Fundus photo. Axial length 23.51 mm. Captured on a Topcon TRC-NW400 fundus camera. 30° FOV. Corneal thickness: 479 µm. Non-mydriatic acquisition. 2212 x 1661 pixels.
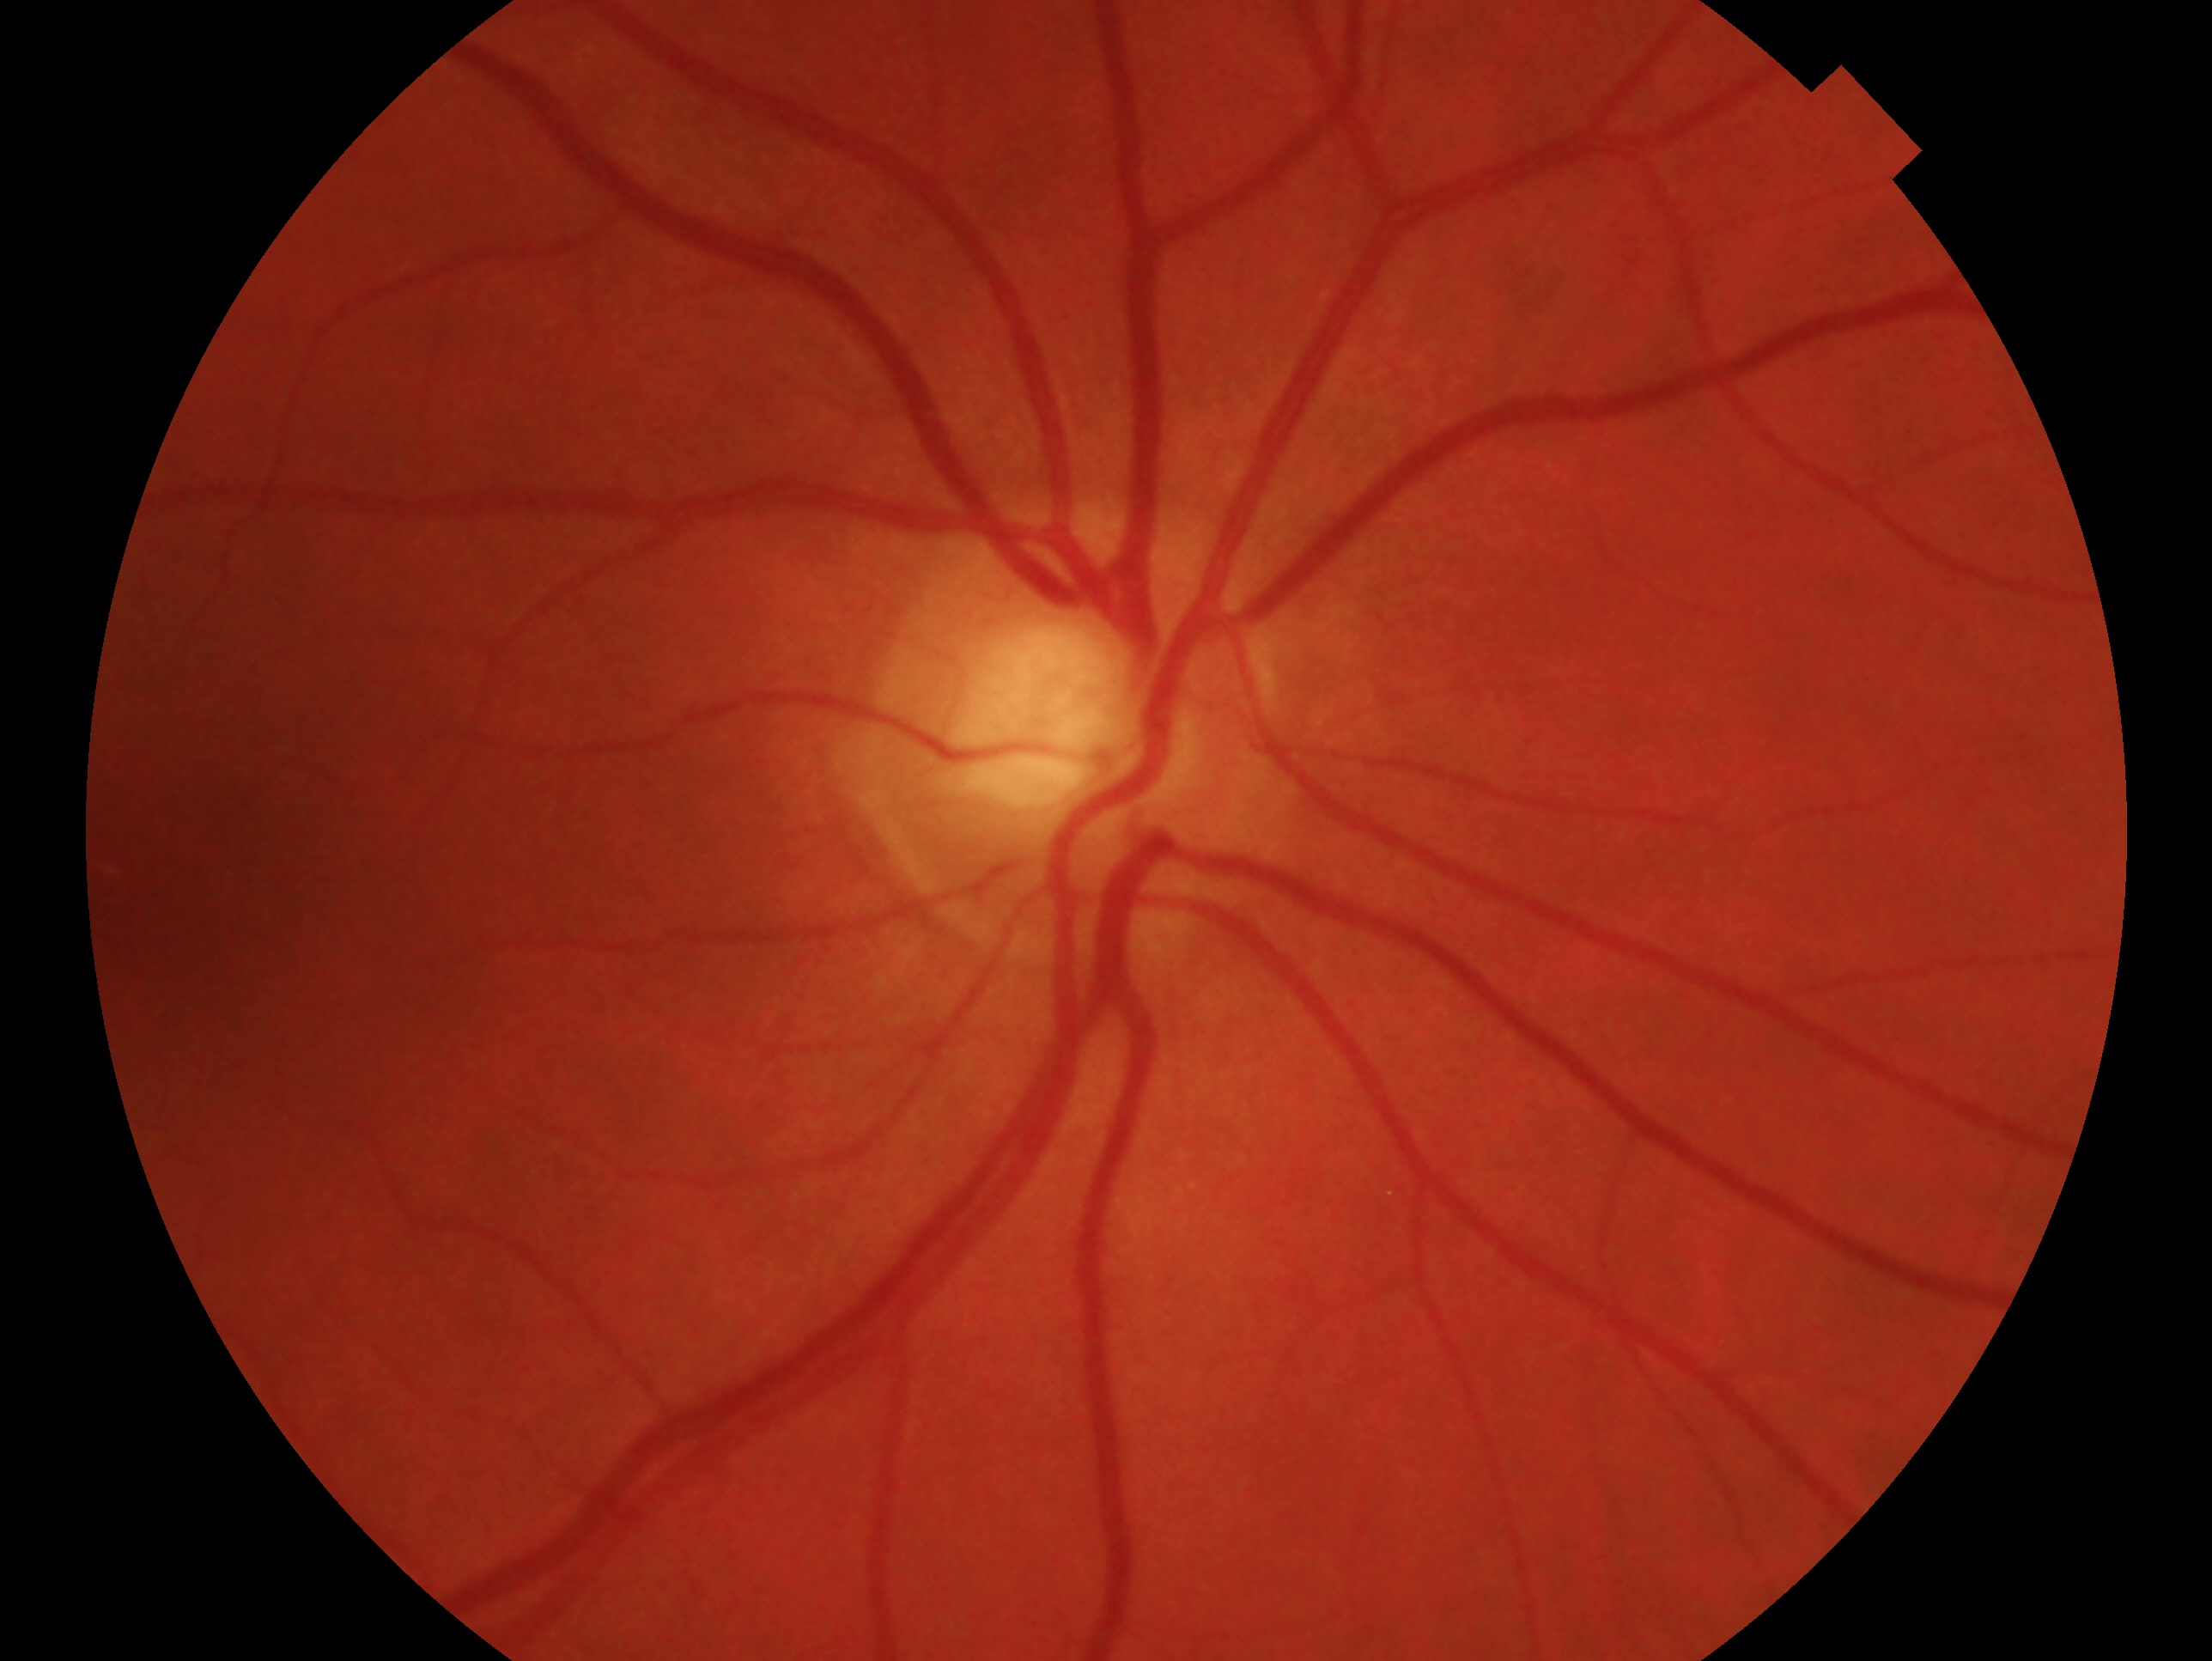 Clinical classification: no glaucoma. Imaged eye: OD.